CFP. 848x848. NIDEK AFC-230:
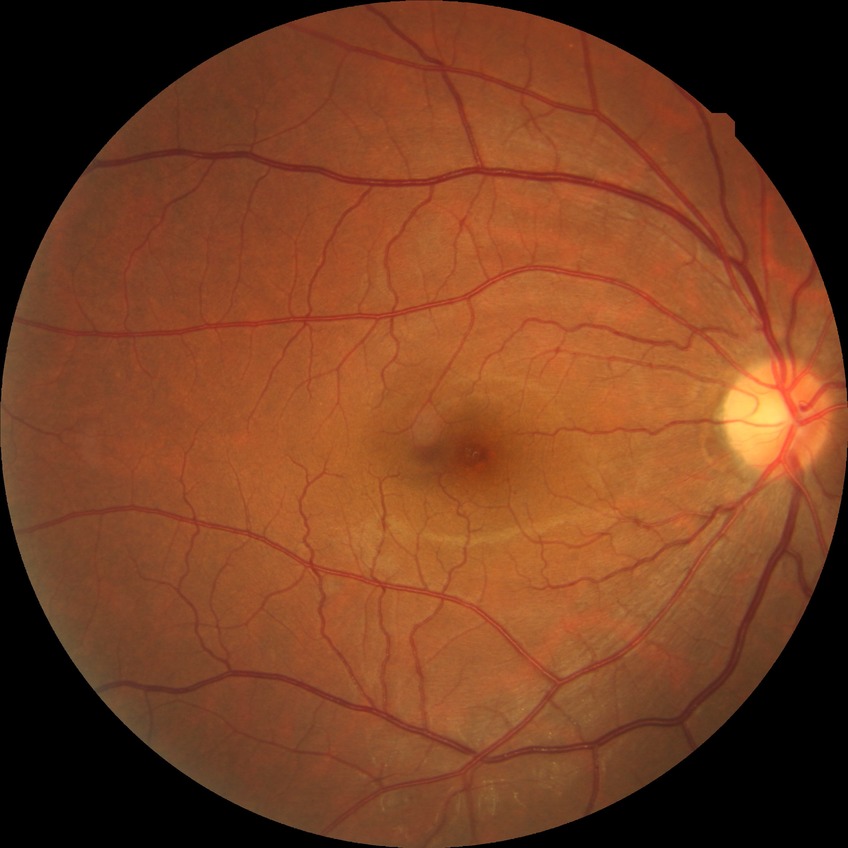
diabetic retinopathy (DR): no diabetic retinopathy (NDR).